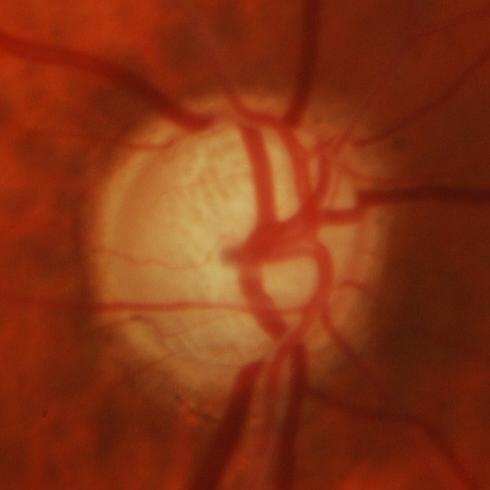 Q: Glaucoma assessment?
A: Glaucoma.